45° field of view.
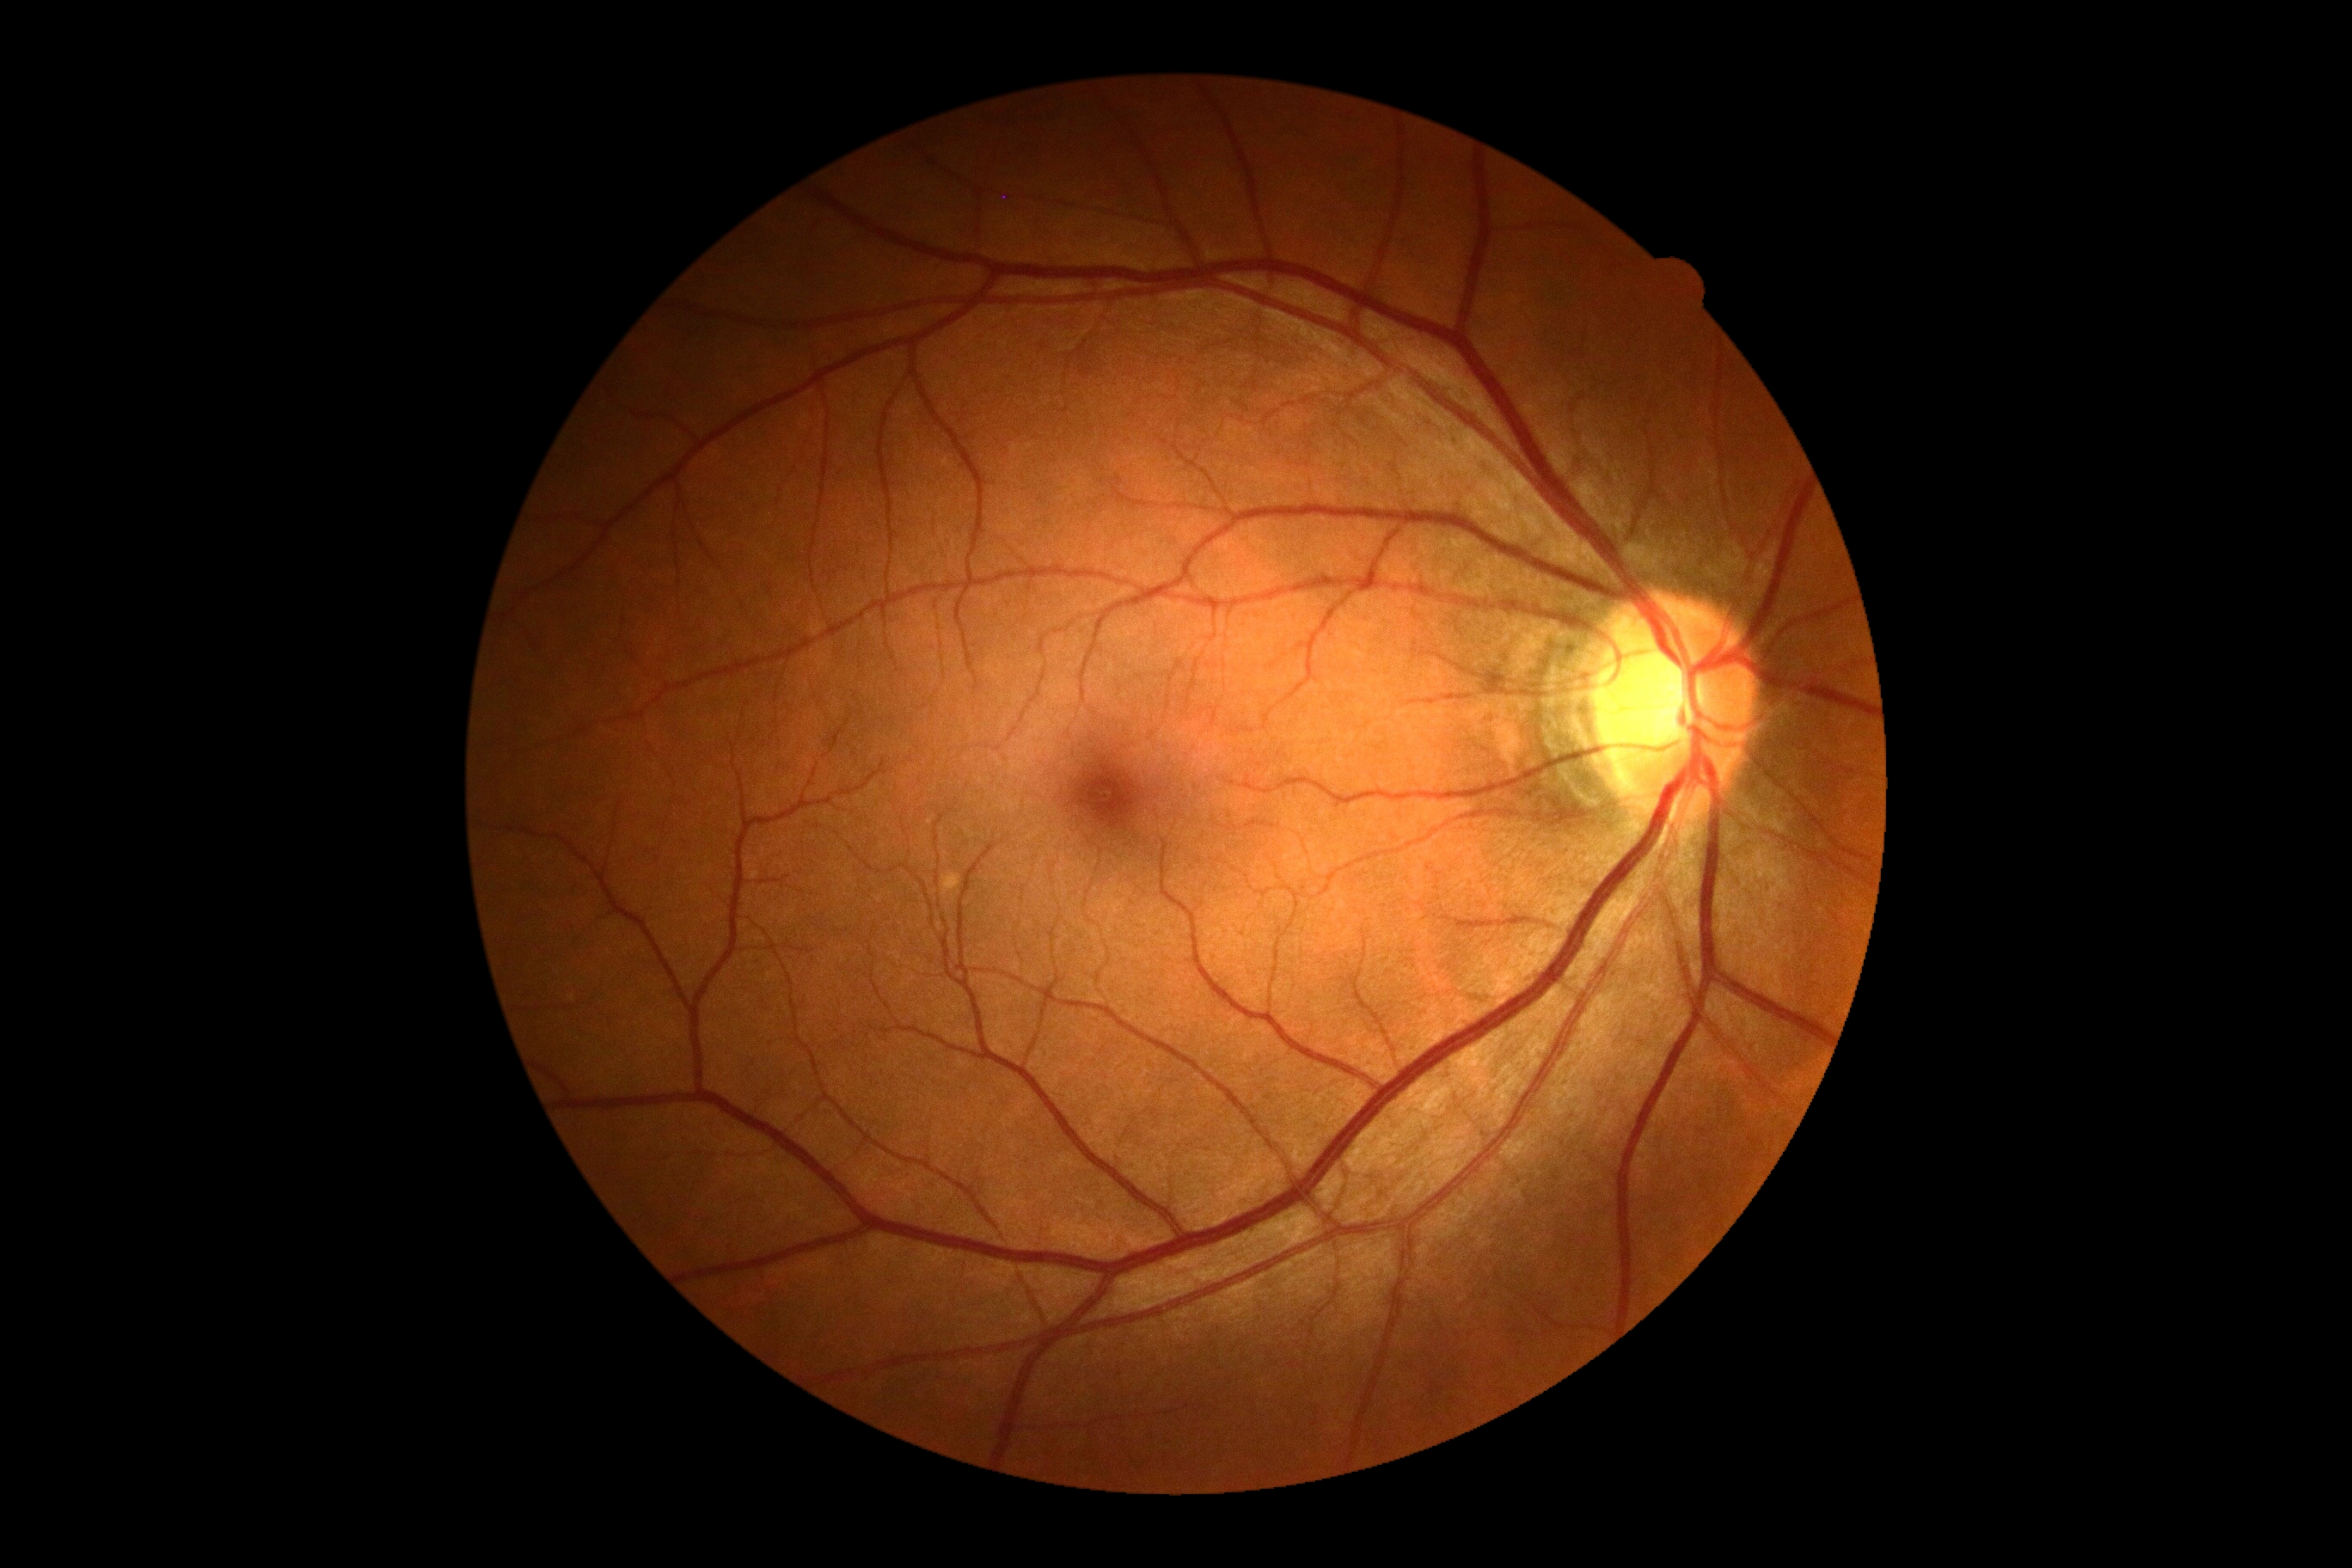

Diabetic retinopathy severity is 0.